Fundus photo:
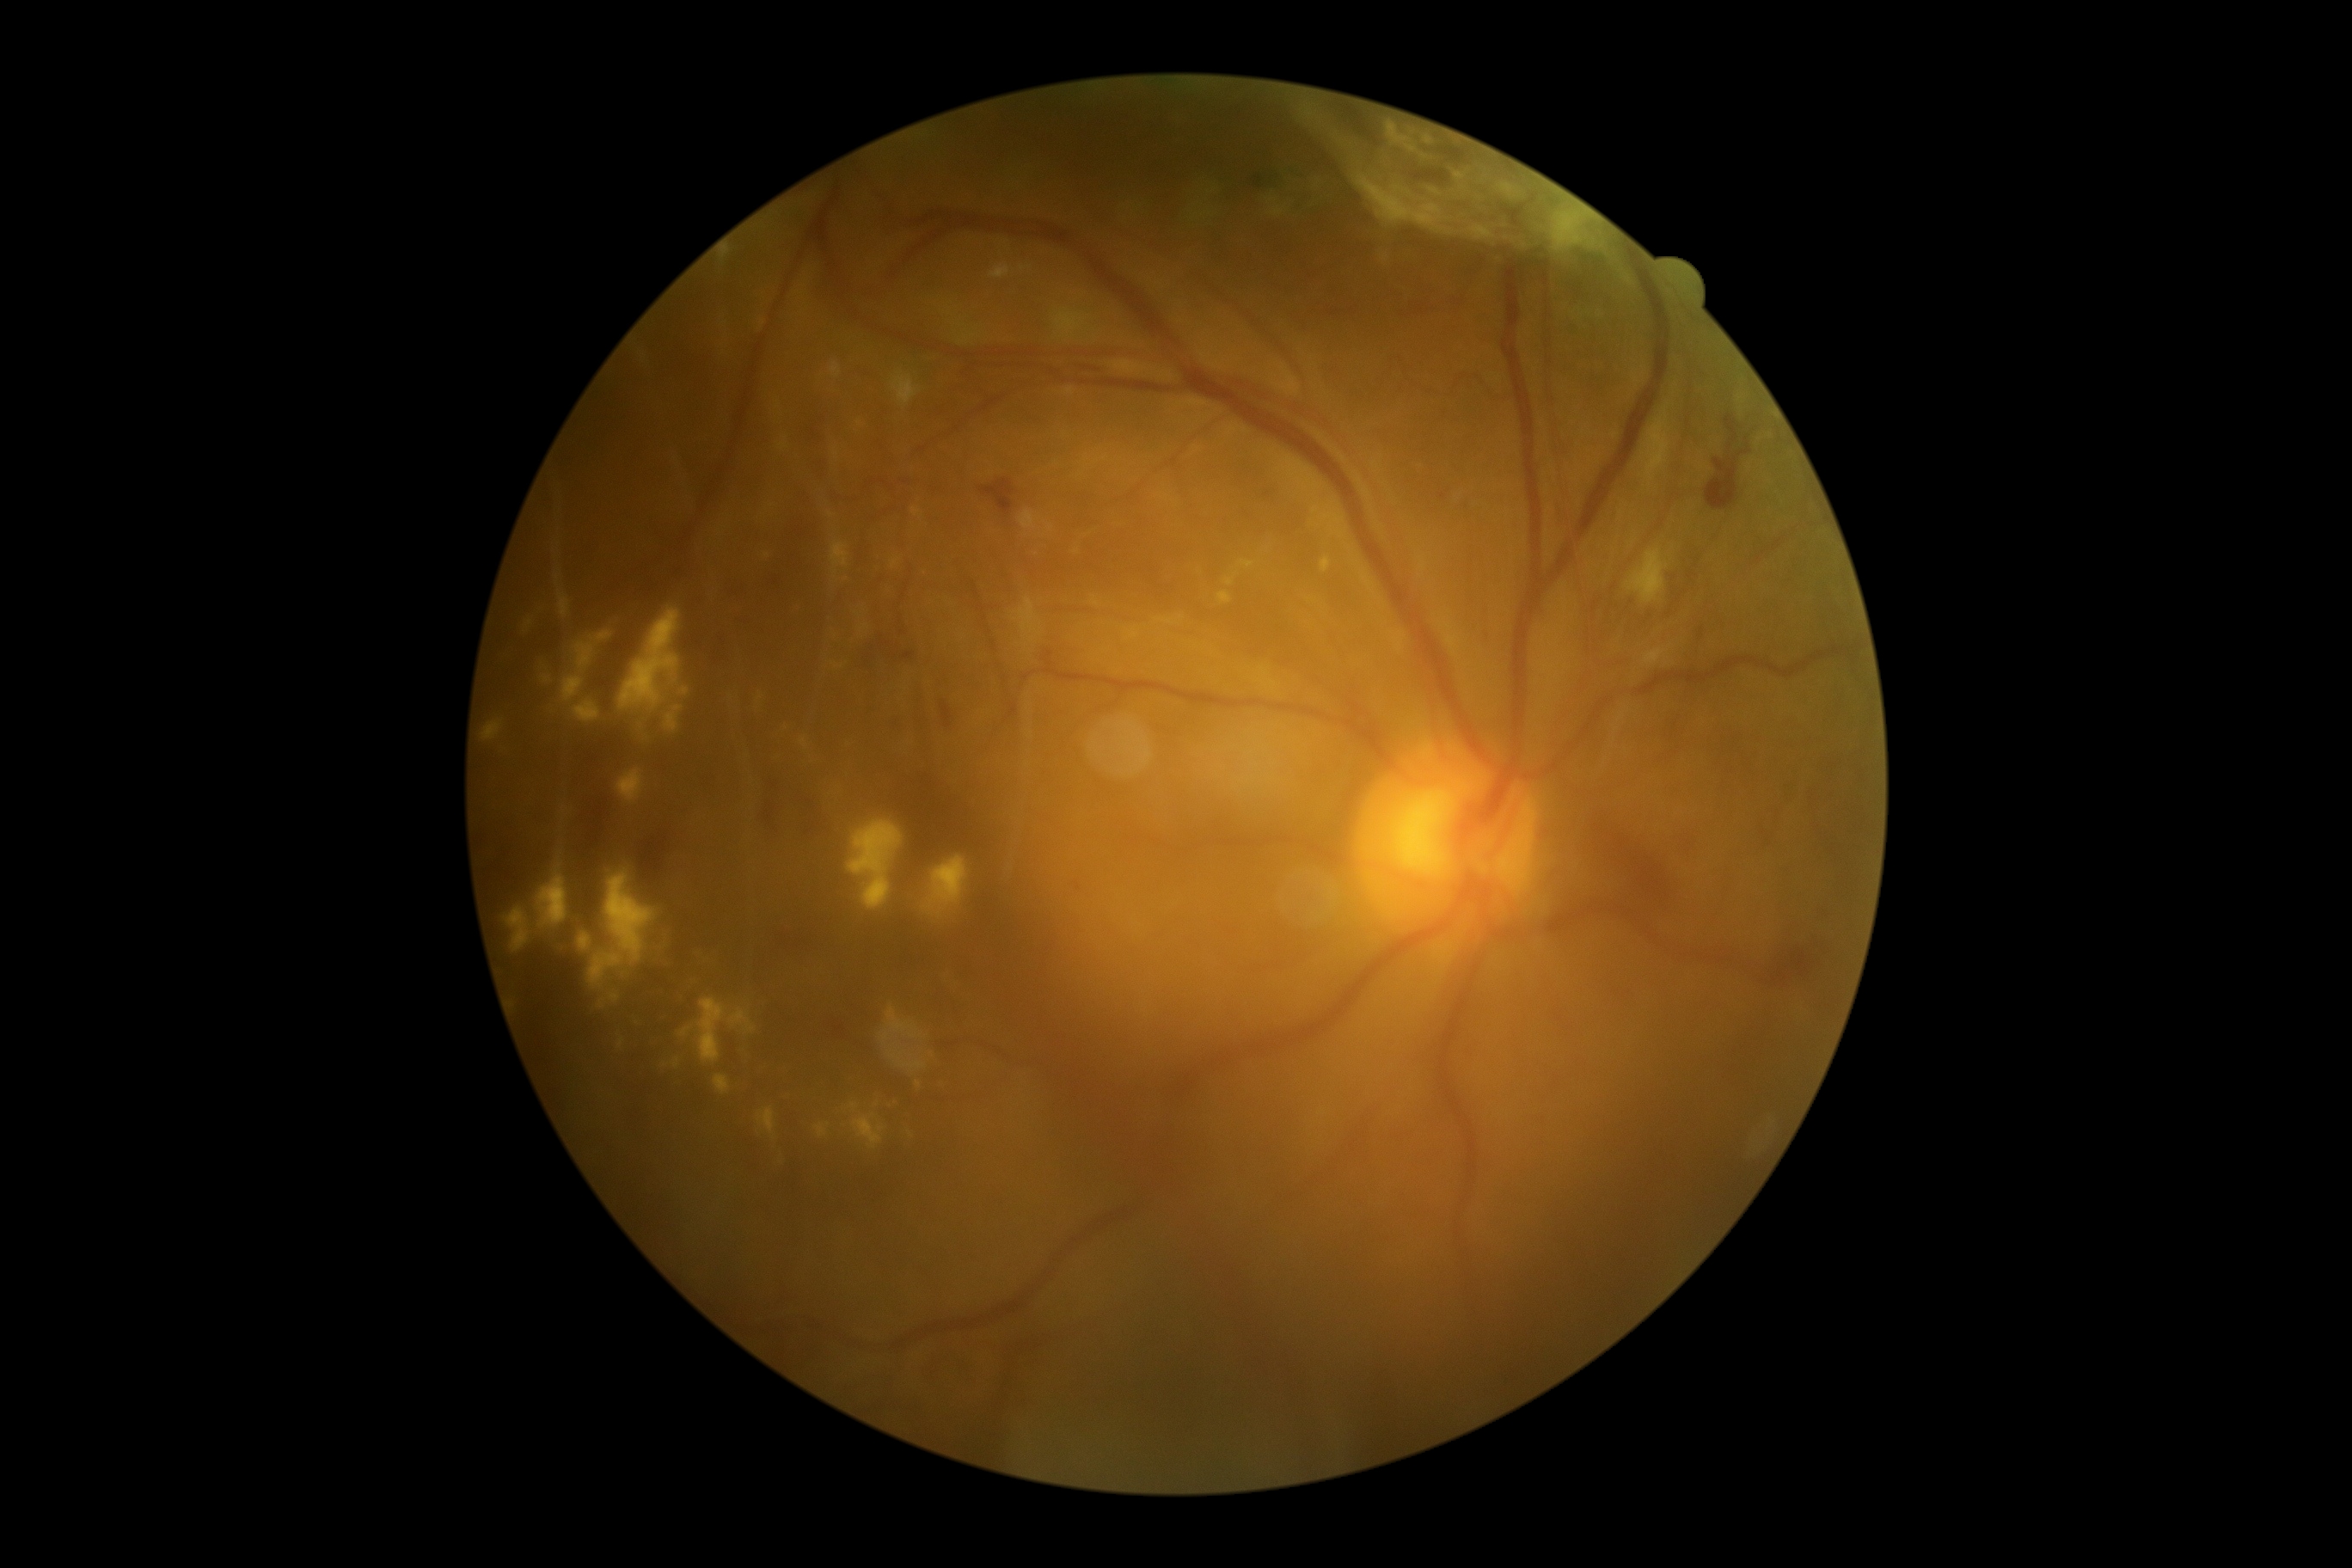 Diabetic retinopathy grade: PDR (4) — neovascularization and/or vitreous/pre-retinal hemorrhage
Selected lesions:
hard exudates (continued): {"left": 1225, "top": 580, "right": 1234, "bottom": 587}, {"left": 831, "top": 663, "right": 843, "bottom": 670}, {"left": 891, "top": 560, "right": 900, "bottom": 568}, {"left": 1239, "top": 560, "right": 1254, "bottom": 568}, {"left": 529, "top": 603, "right": 699, "bottom": 750}, {"left": 859, "top": 625, "right": 869, "bottom": 632}, {"left": 1014, "top": 597, "right": 1043, "bottom": 644}, {"left": 830, "top": 362, "right": 842, "bottom": 379}, {"left": 1321, "top": 558, "right": 1332, "bottom": 573}, {"left": 756, "top": 692, "right": 764, "bottom": 706}, {"left": 616, "top": 769, "right": 646, "bottom": 807}, {"left": 482, "top": 720, "right": 505, "bottom": 742}, {"left": 1019, "top": 510, "right": 1036, "bottom": 530}, {"left": 933, "top": 855, "right": 969, "bottom": 917}
Hard exudates (small, approximate centers) near [831, 514], [846, 580], [778, 405], [766, 556], [1077, 552]
hemorrhages (continued): {"left": 1600, "top": 542, "right": 1713, "bottom": 652}, {"left": 922, "top": 1356, "right": 976, "bottom": 1388}, {"left": 721, "top": 1027, "right": 745, "bottom": 1081}, {"left": 1803, "top": 749, "right": 1875, "bottom": 902}, {"left": 763, "top": 780, "right": 835, "bottom": 836}, {"left": 768, "top": 573, "right": 787, "bottom": 597}, {"left": 821, "top": 1015, "right": 848, "bottom": 1044}, {"left": 1693, "top": 625, "right": 1710, "bottom": 640}, {"left": 1725, "top": 415, "right": 1739, "bottom": 443}, {"left": 1069, "top": 876, "right": 1091, "bottom": 900}, {"left": 773, "top": 917, "right": 836, "bottom": 967}, {"left": 711, "top": 637, "right": 730, "bottom": 677}, {"left": 1772, "top": 934, "right": 1830, "bottom": 983}, {"left": 1703, "top": 730, "right": 1753, "bottom": 773}, {"left": 733, "top": 611, "right": 756, "bottom": 632}
Hemorrhages (small, approximate centers) near [1443, 496]